Color fundus photograph.
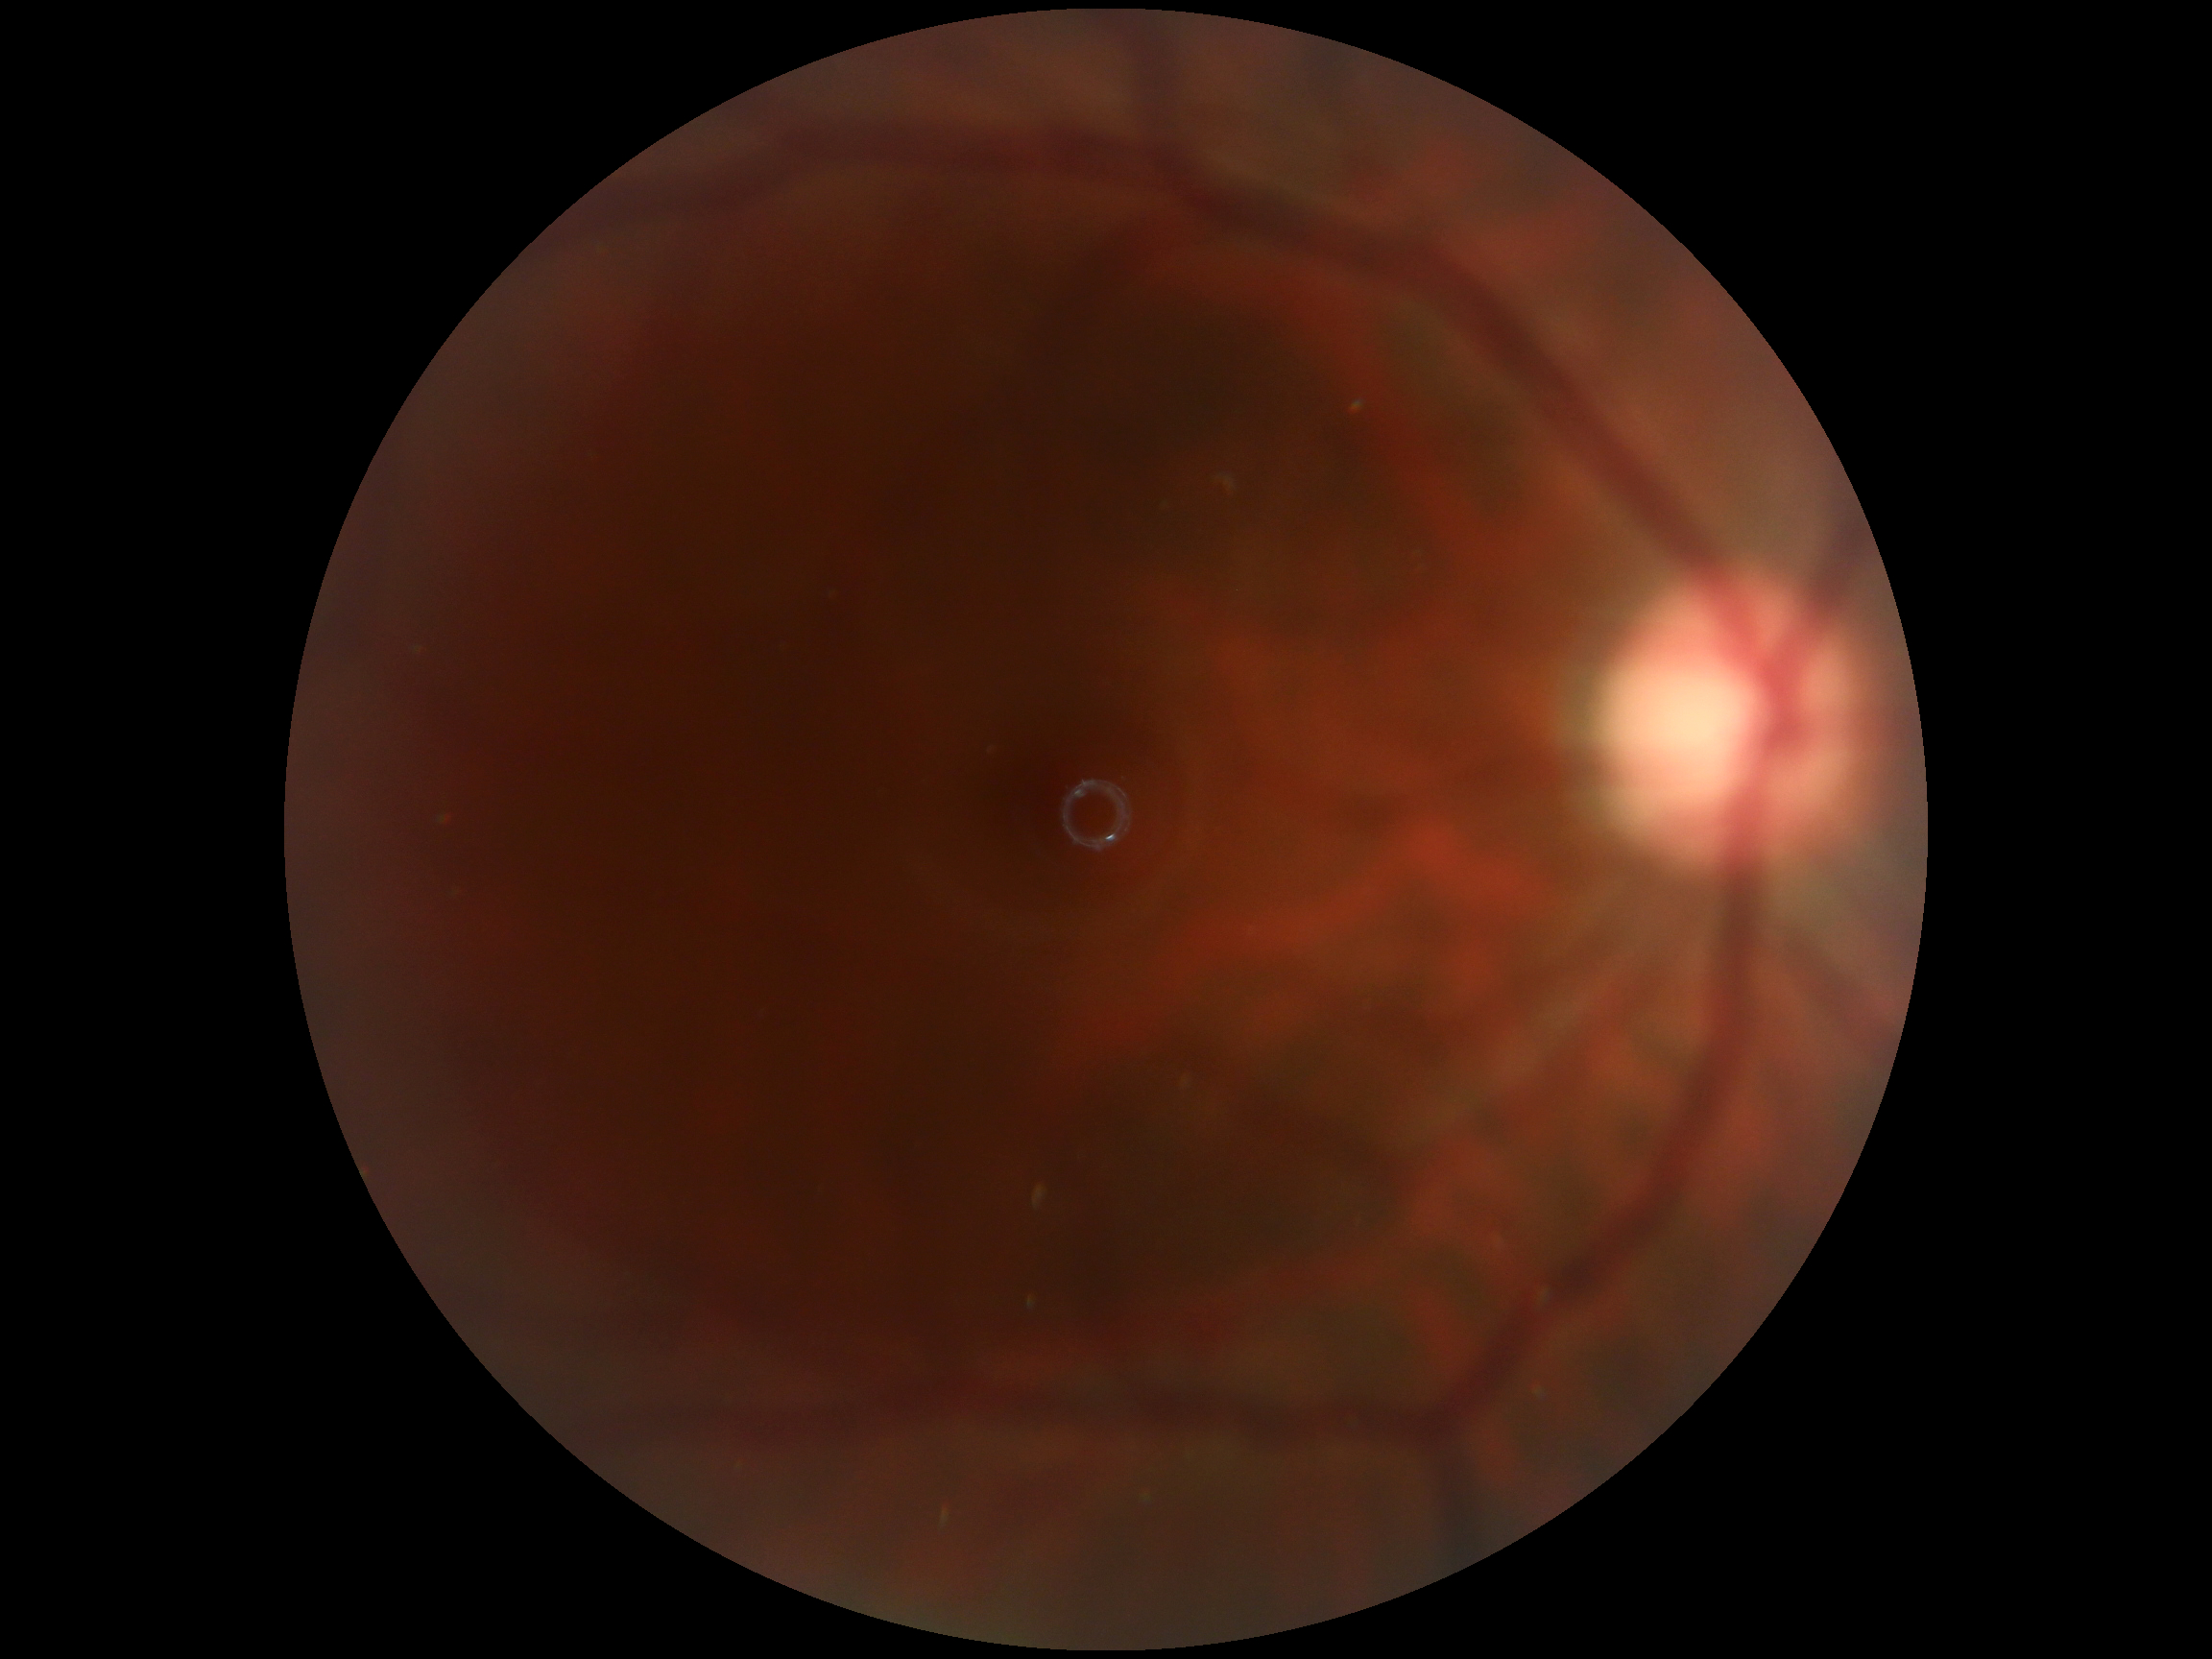
DR impression = no signs of DR
diabetic retinopathy = no apparent diabetic retinopathy (grade 0)